240 x 240 pixels:
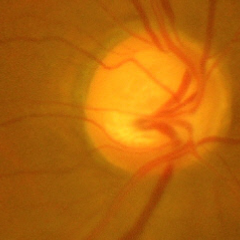 Fundus appearance consistent with advanced-stage glaucoma.